2352 x 1568 pixels:
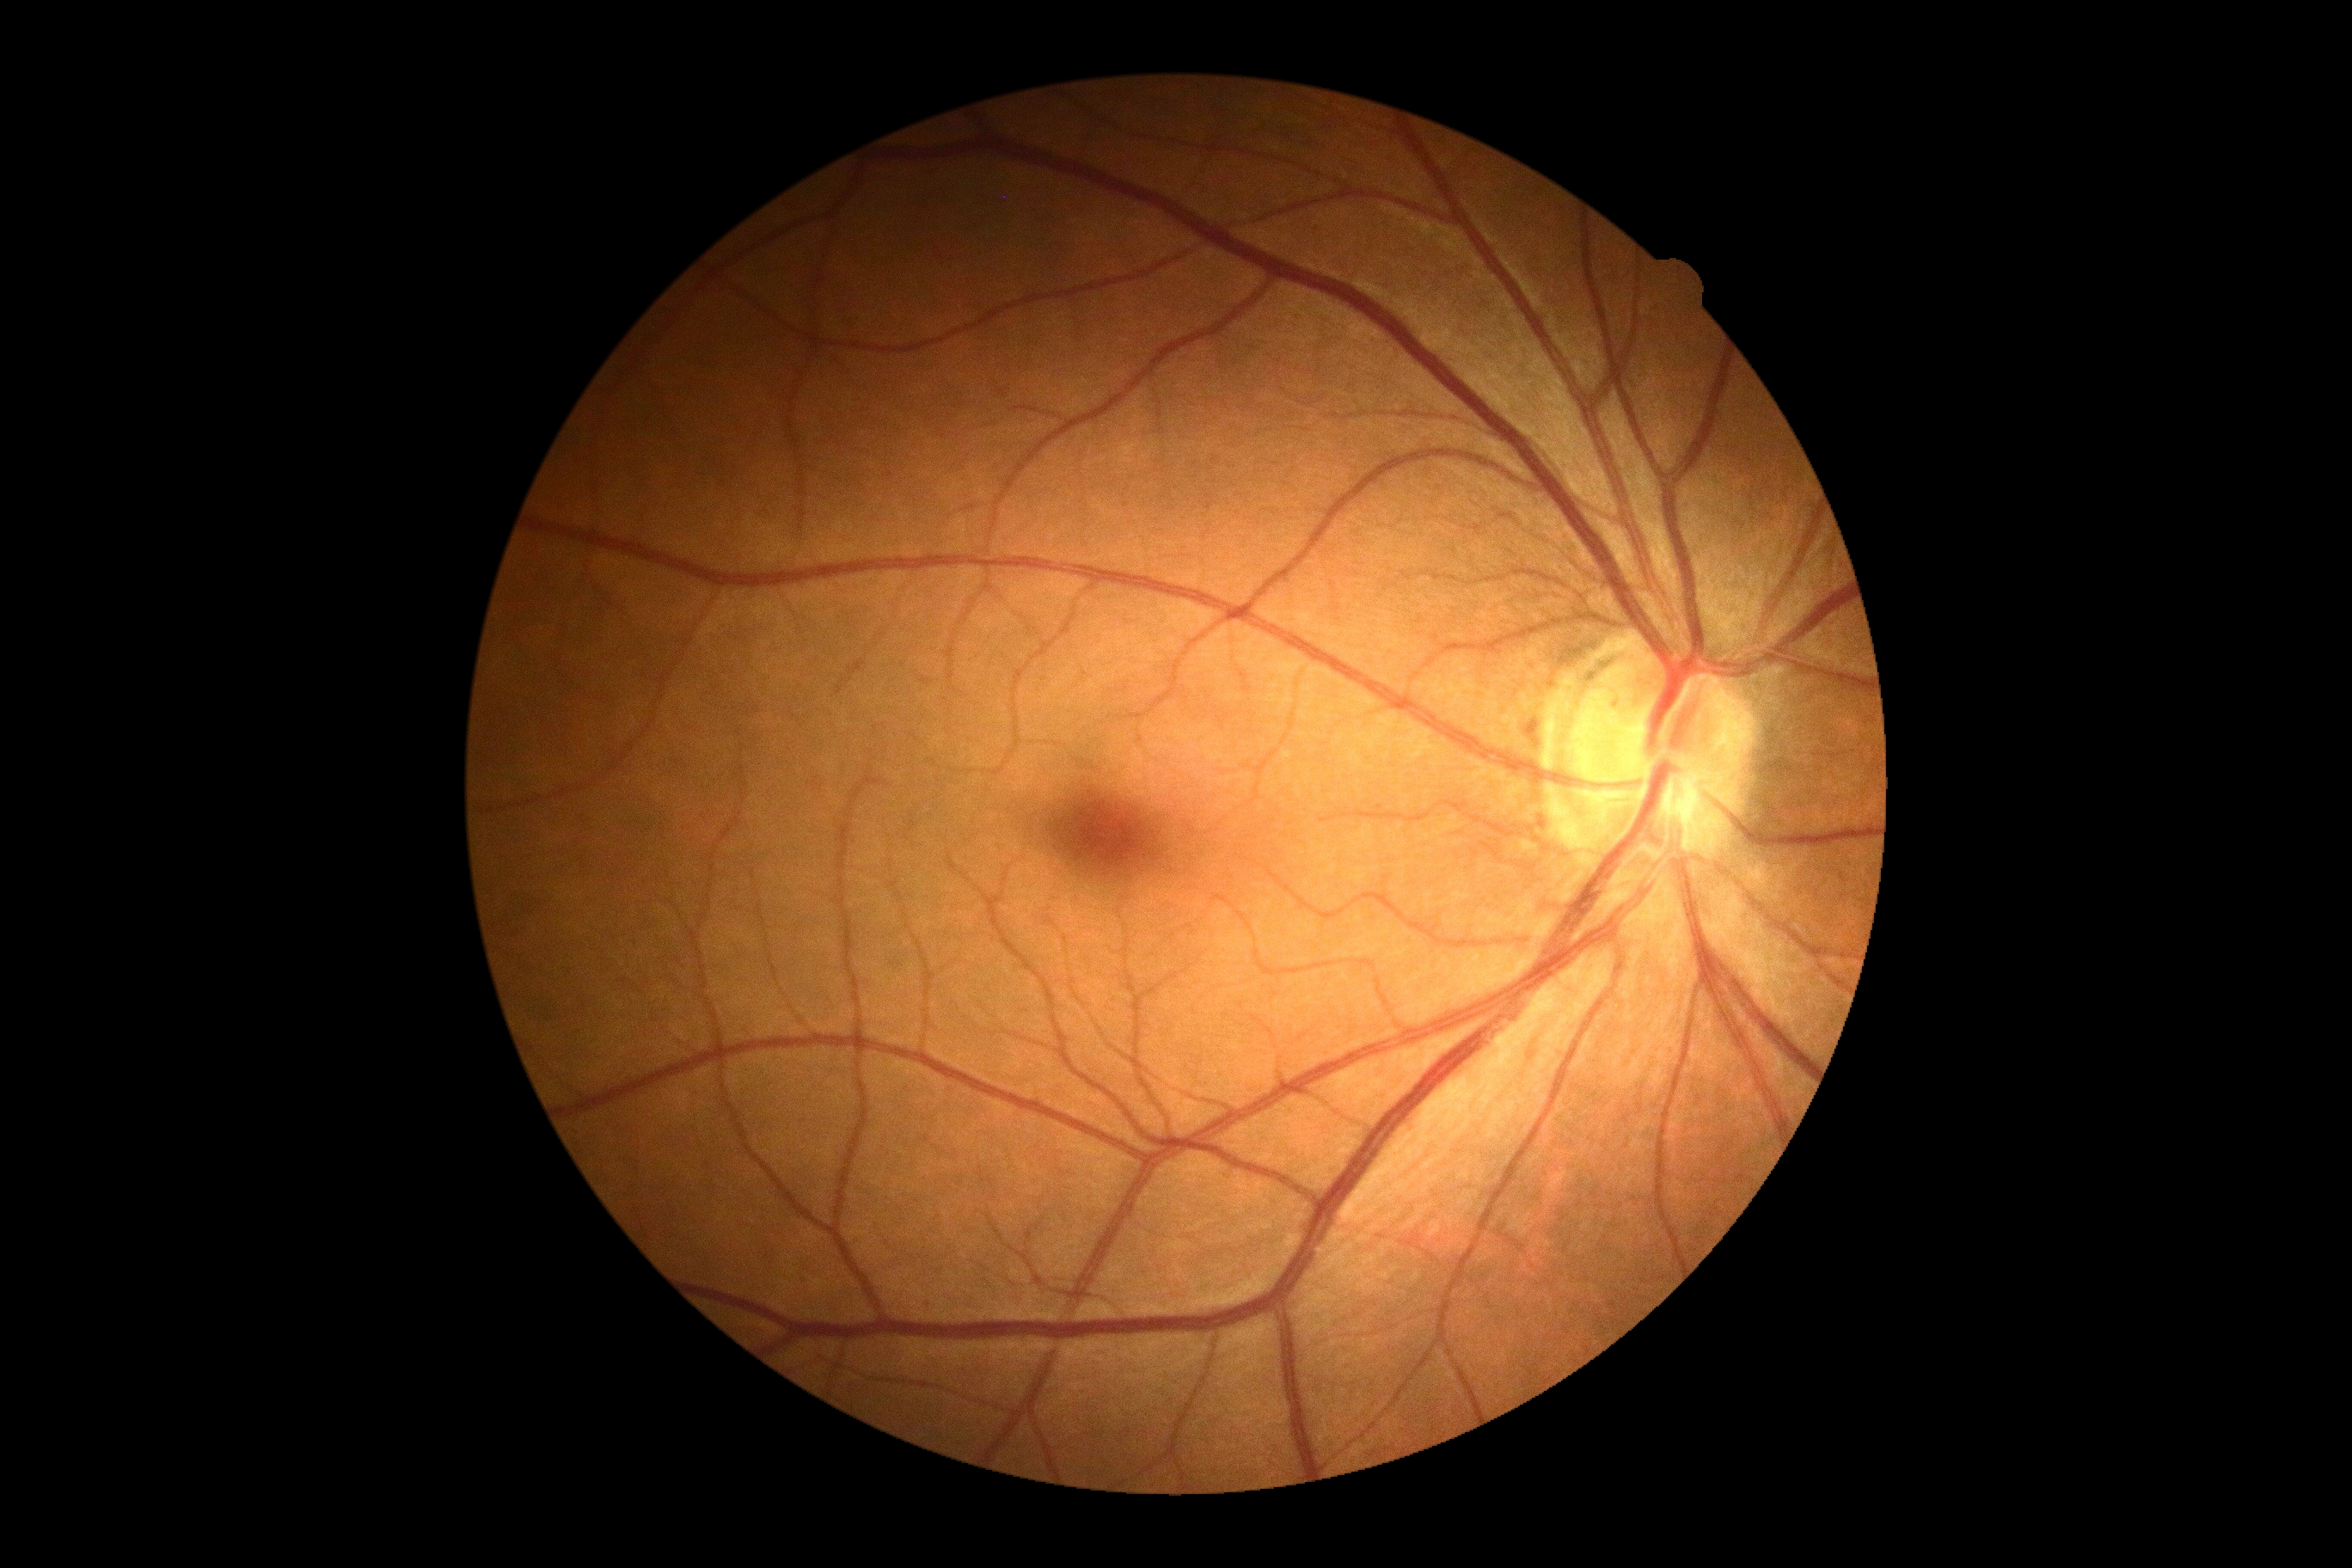

- DR stage — no apparent retinopathy (grade 0)